CFP: 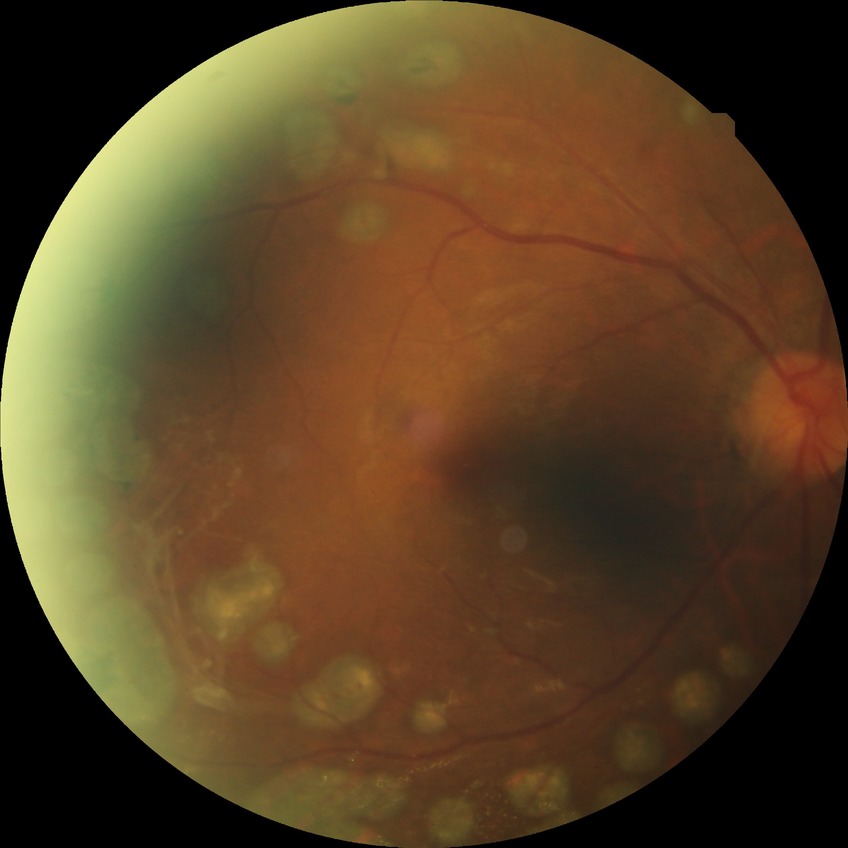
Diabetic retinopathy (DR) is PDR (proliferative diabetic retinopathy).